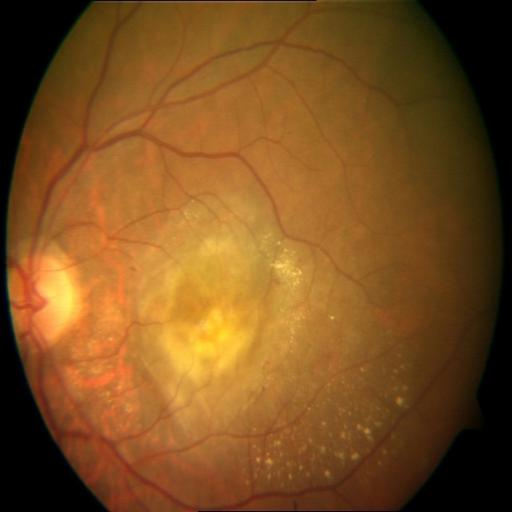

Findings: MS (macular scar); EDN (exudation).